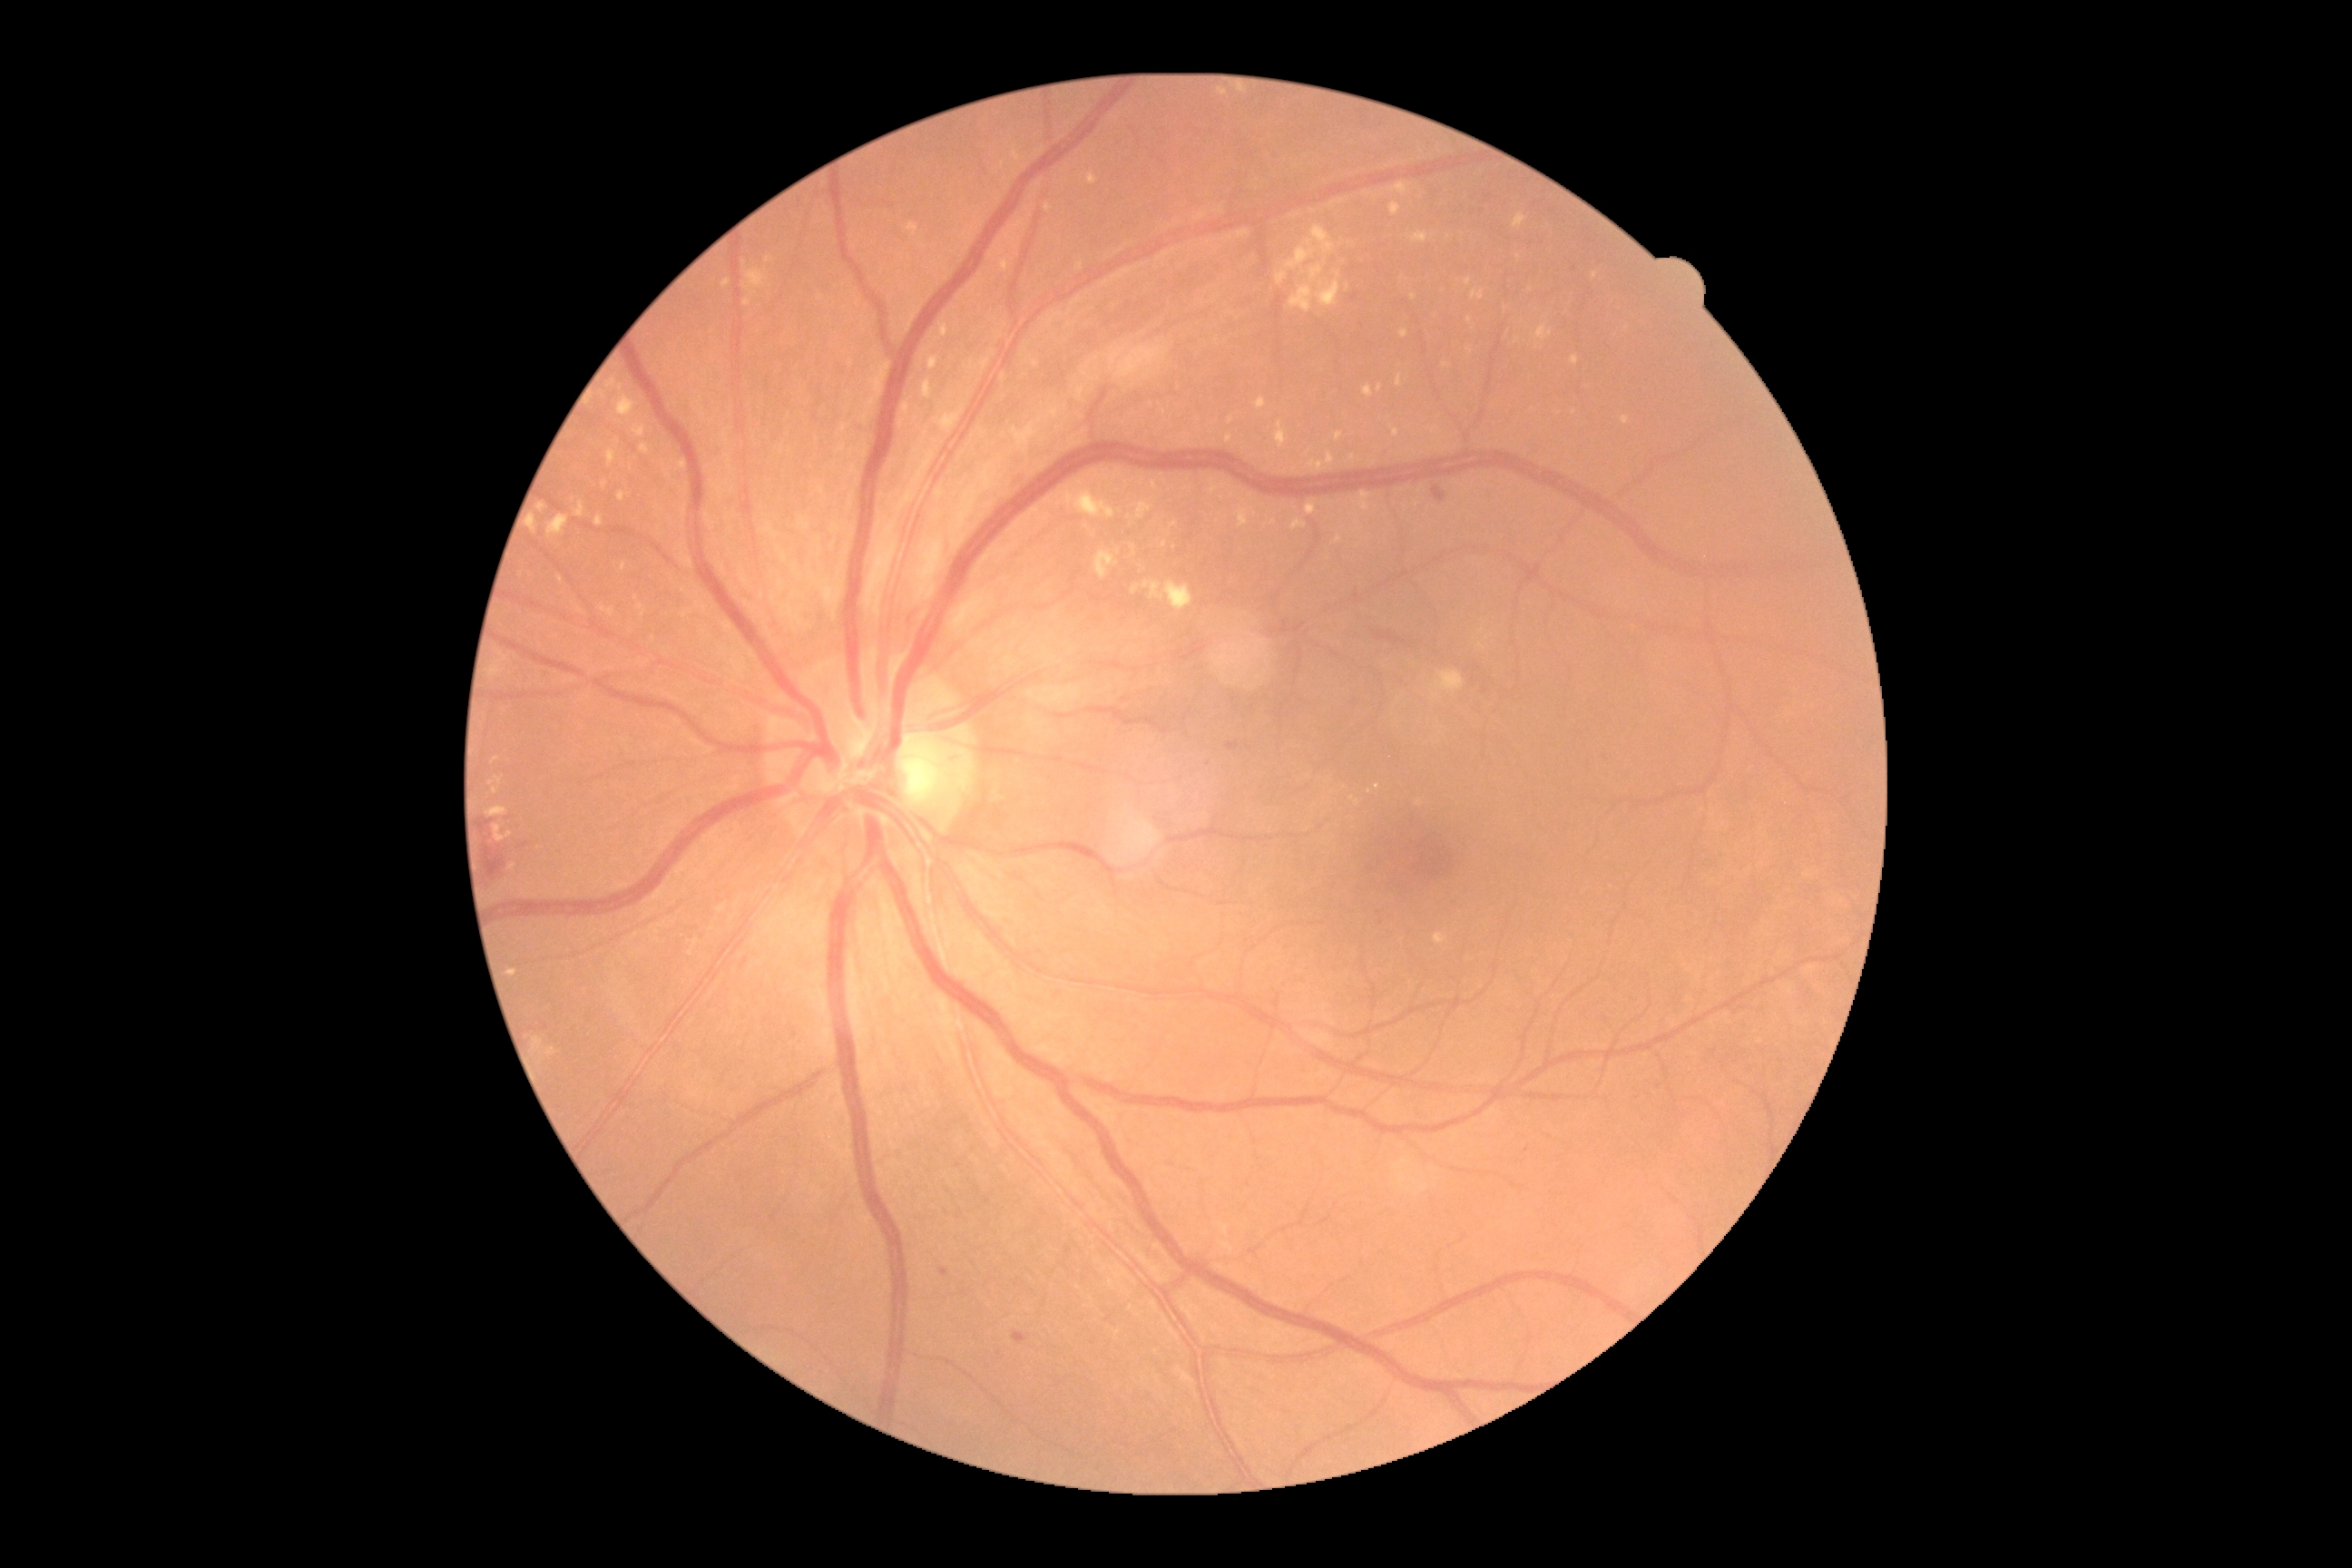 The retinopathy is classified as non-proliferative diabetic retinopathy.
Diabetic retinopathy is 2.